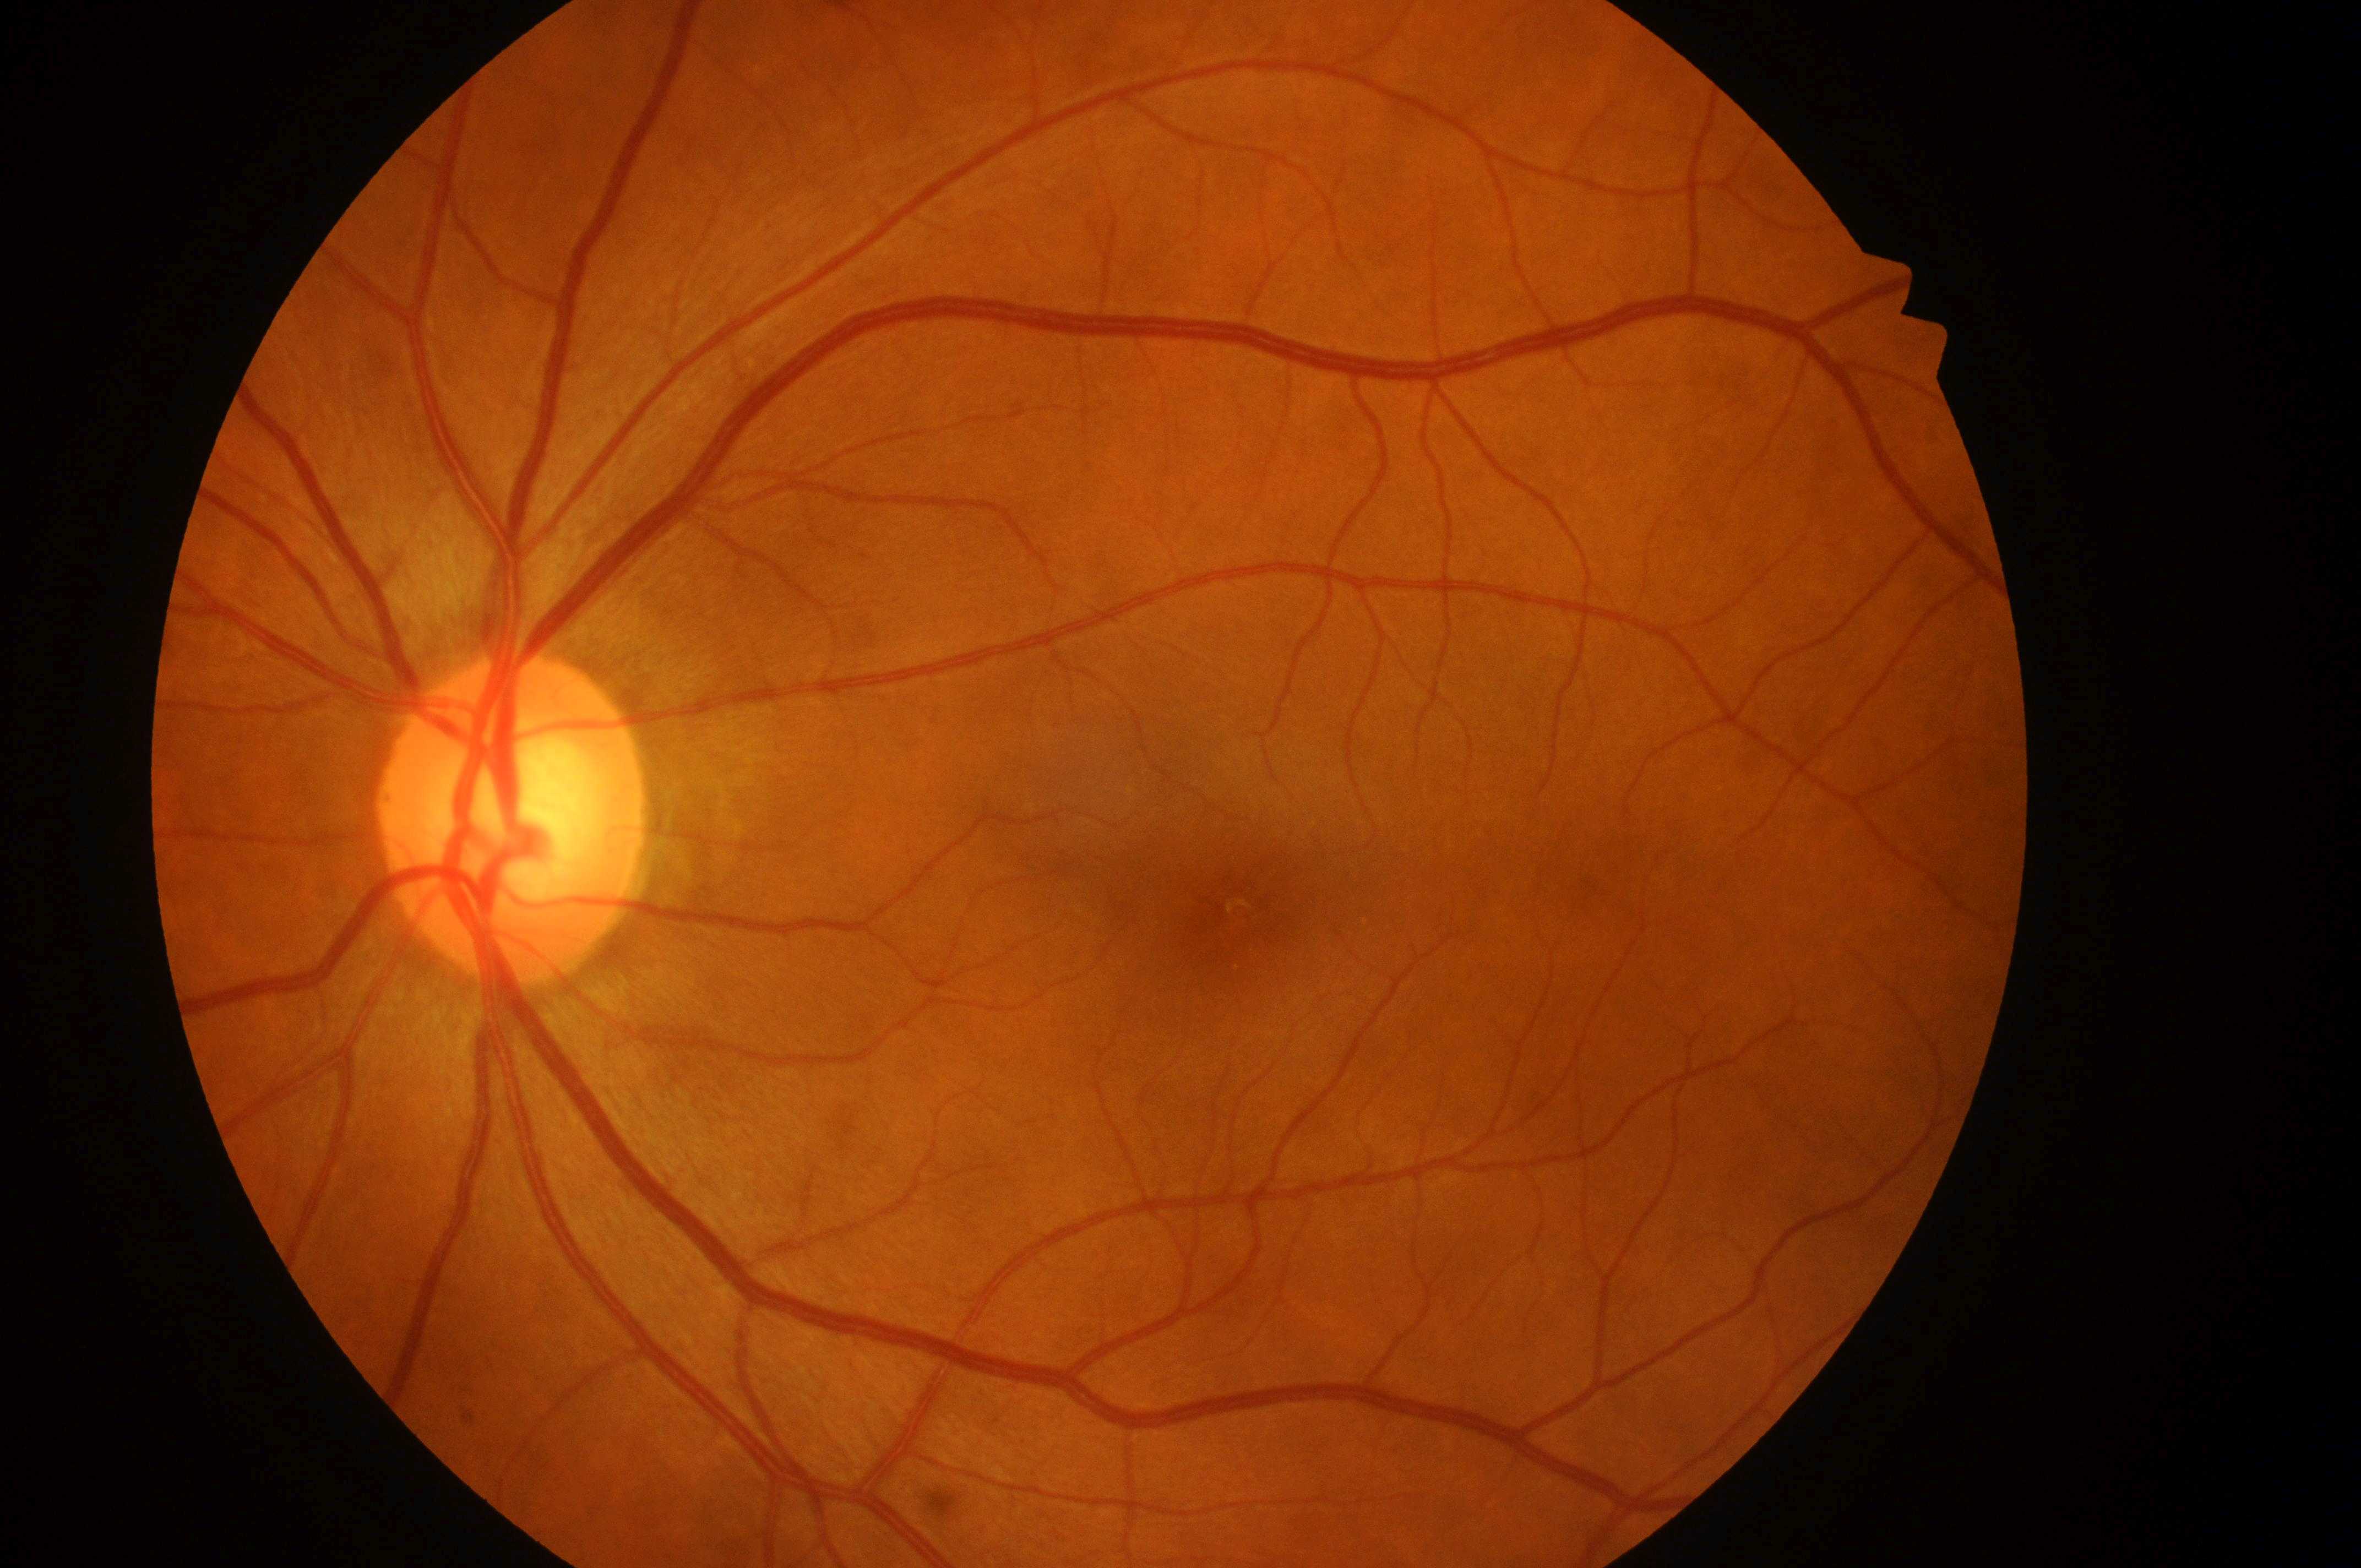 The image shows the left eye.
Fovea centralis: [1236, 917].
DR grade is no apparent diabetic retinopathy (0).
ONH: [509, 831].
No signs of diabetic retinopathy or diabetic macular edema.
DME grade: no risk (0).